Posterior pole photograph; modified Davis classification — 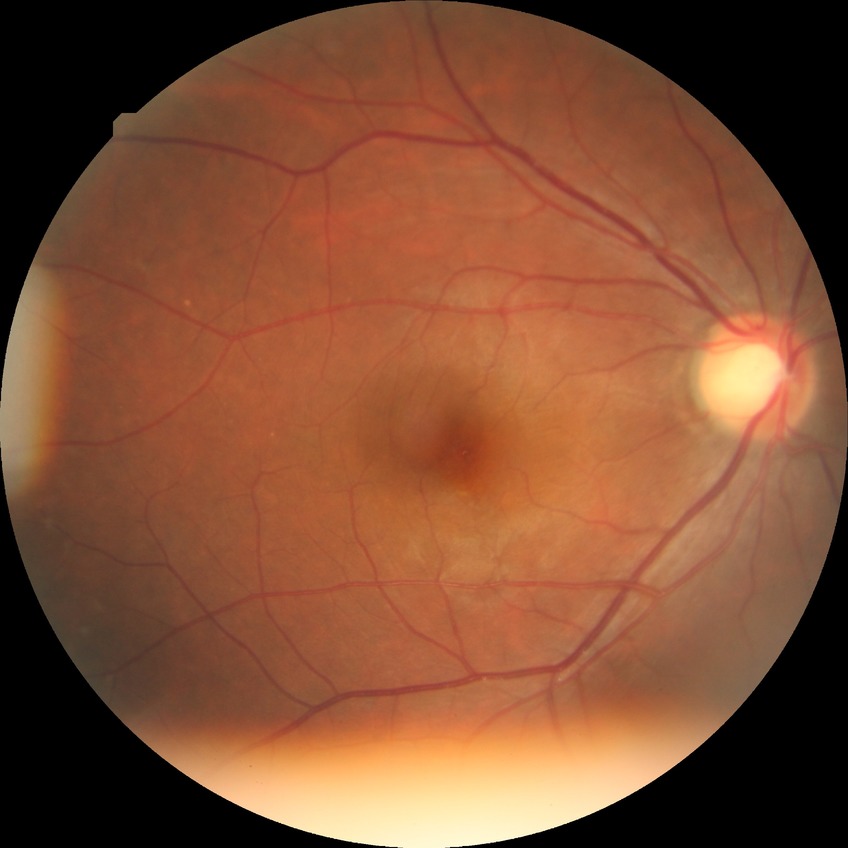

Retinopathy stage: no diabetic retinopathy.